Camera: NIDEK AFC-230. Fundus photo. 45° FOV. 848x848px. Nonmydriatic — 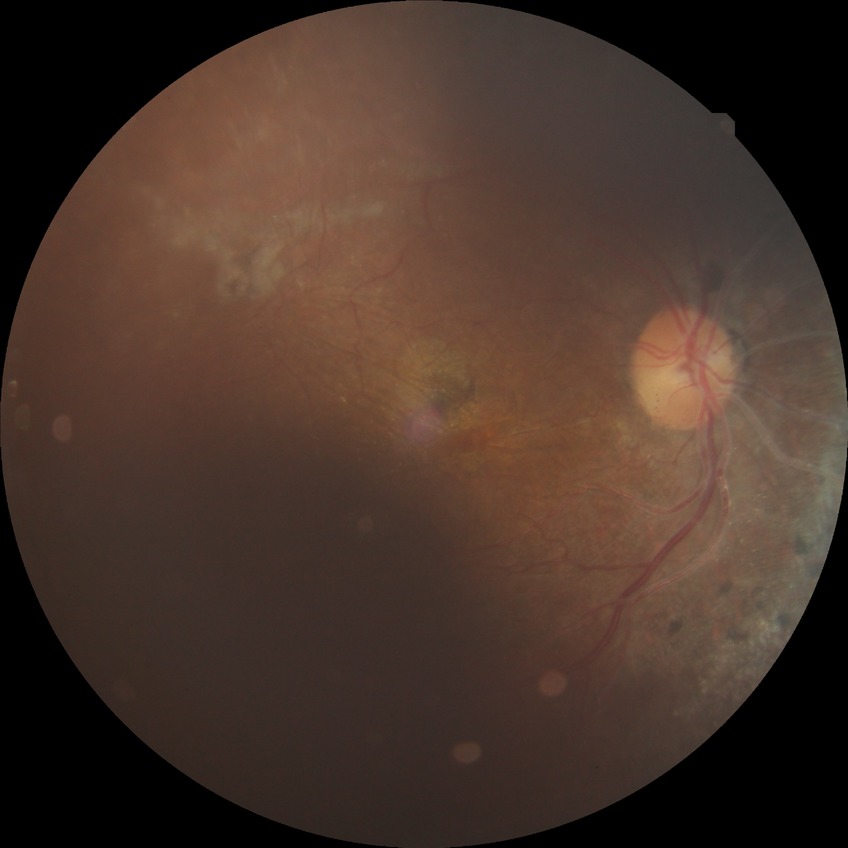
Davis grading: proliferative diabetic retinopathy.